CFP — 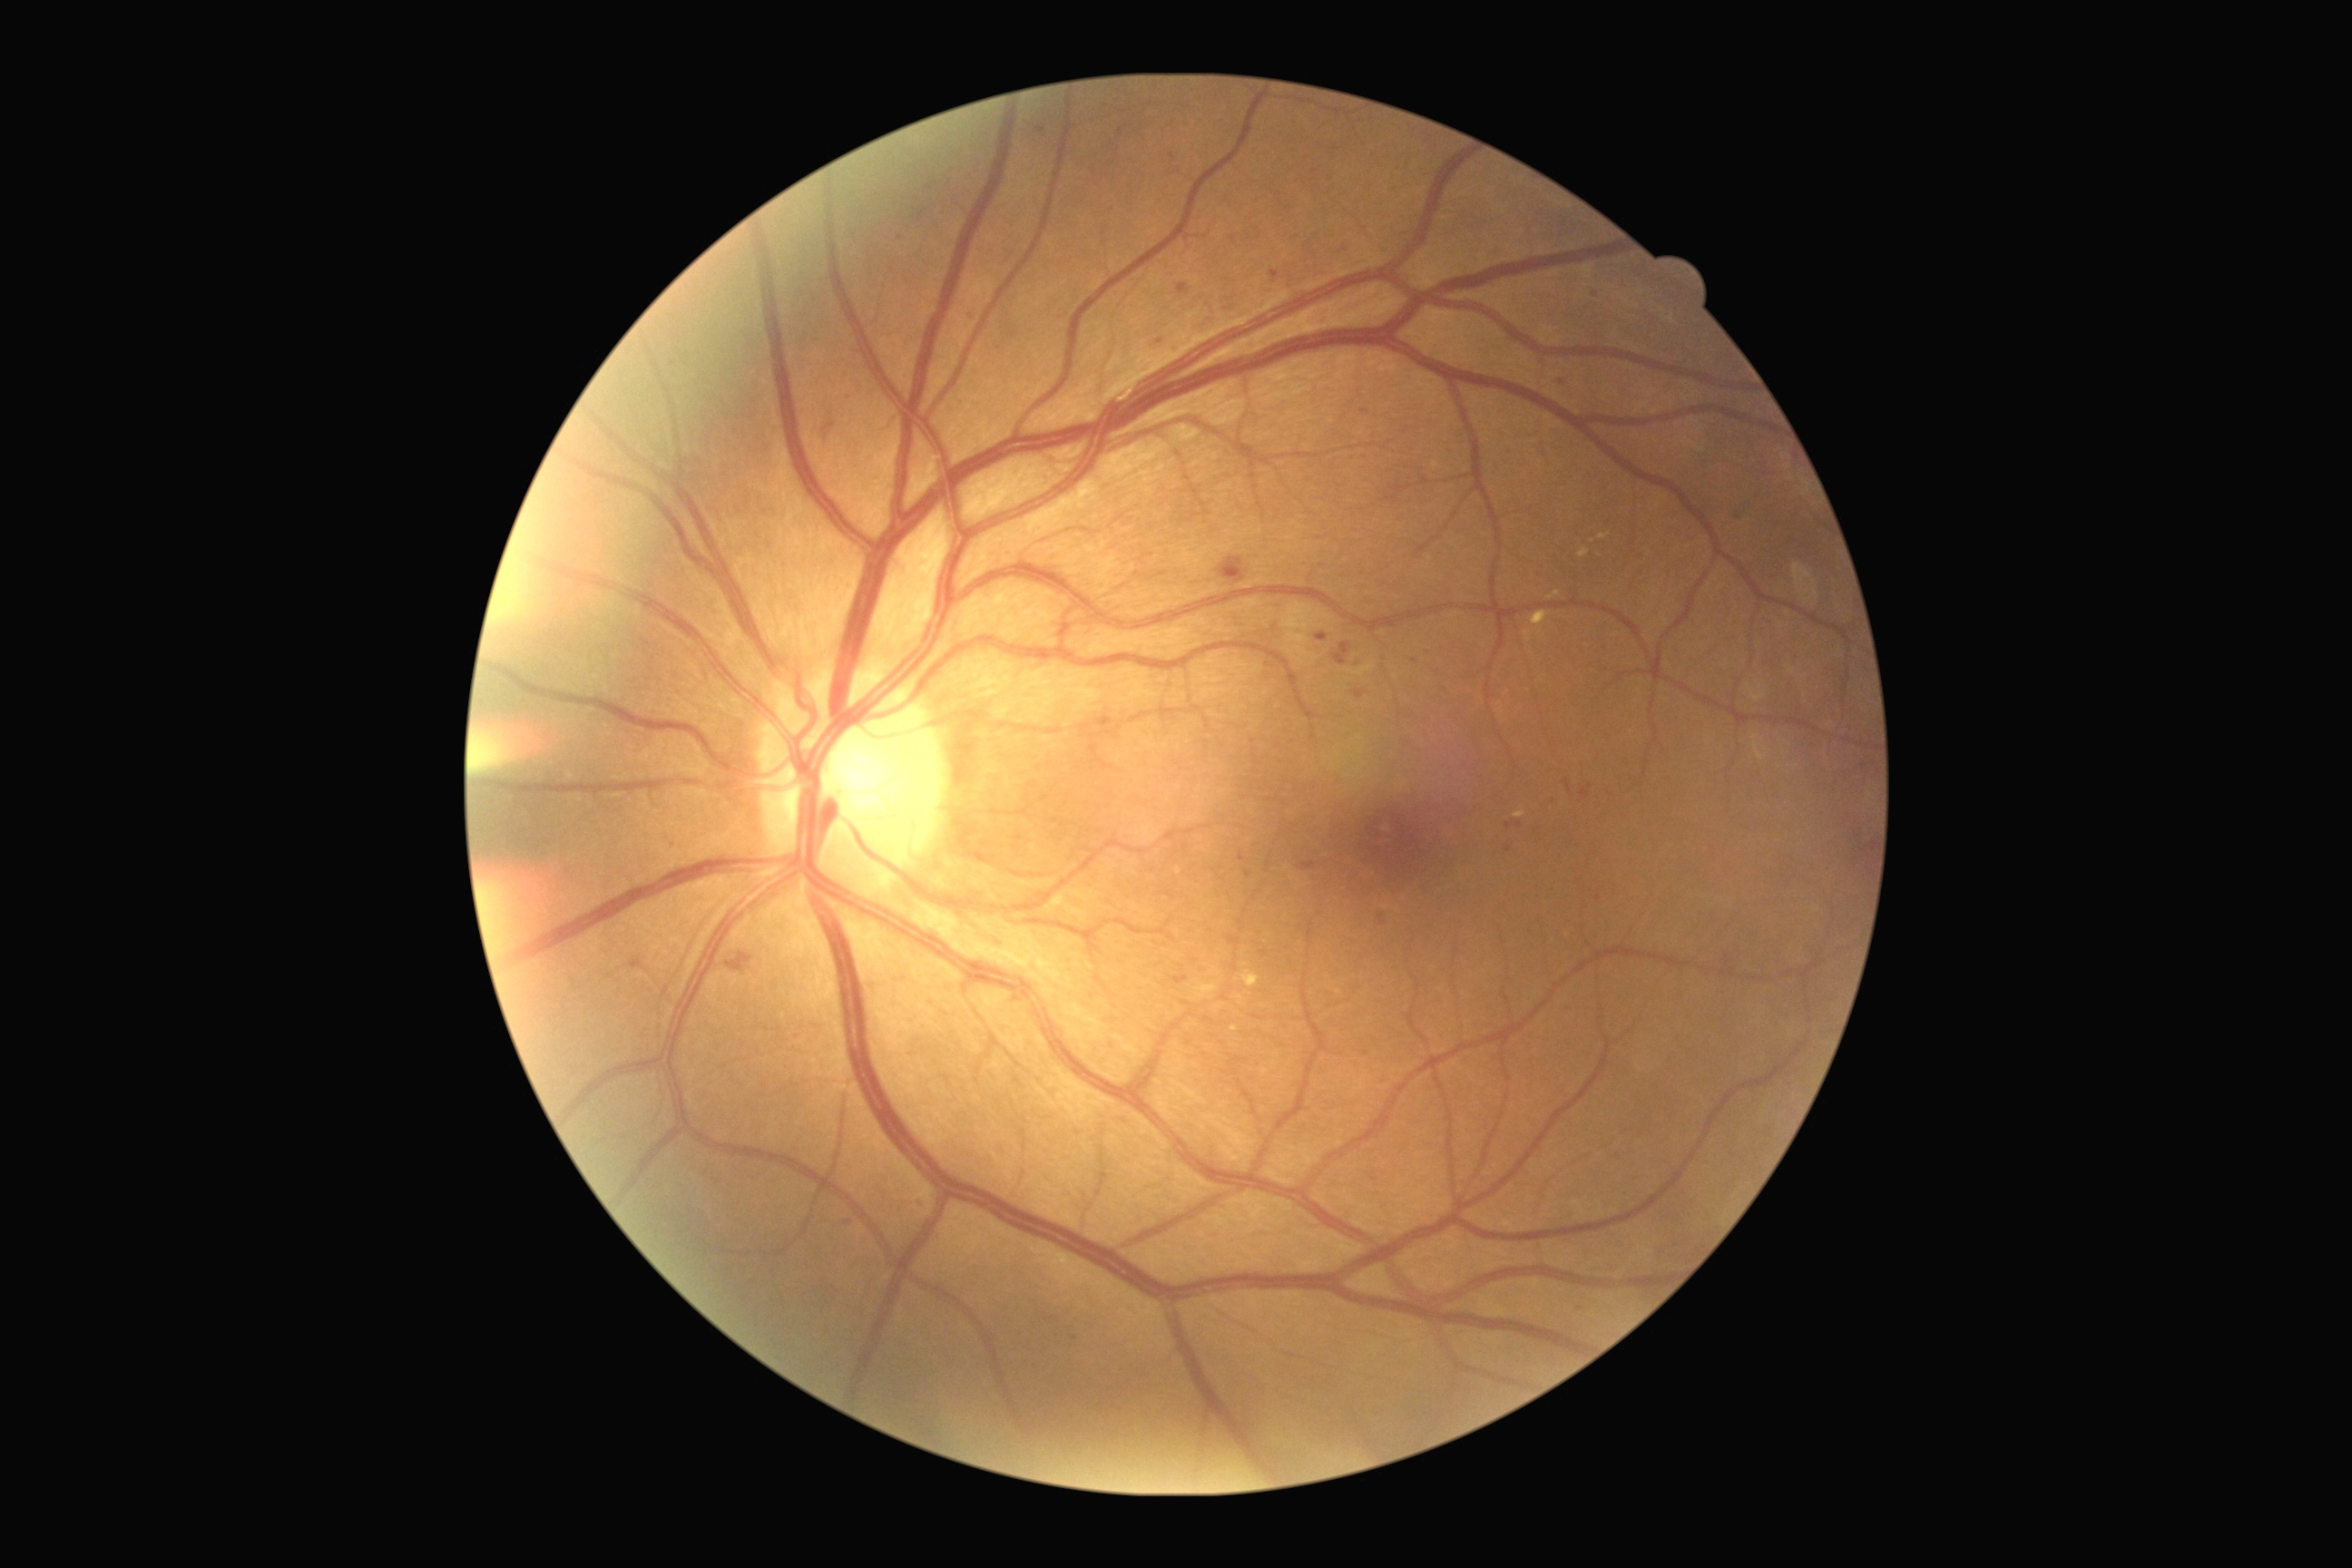

Diabetic retinopathy is grade 2
Representative lesions:
microaneurysms (continued) = region(1097, 718, 1113, 730), region(1580, 790, 1589, 799), region(914, 1199, 925, 1213), region(1177, 284, 1190, 295)
Smaller microaneurysms around pt(1521, 824), pt(1595, 294), pt(1383, 919), pt(1185, 1003), pt(1263, 954), pt(1562, 382), pt(1121, 133), pt(1013, 336), pt(1172, 157), pt(848, 1223)
soft exudates = none detected
hemorrhages = region(729, 952, 756, 981), region(1333, 643, 1351, 665), region(827, 424, 830, 440), region(1219, 558, 1246, 583), region(1725, 946, 1736, 968), region(1315, 634, 1328, 642), region(1353, 691, 1364, 700)
hard exudates (continued) = region(1524, 631, 1531, 642), region(1195, 983, 1219, 999), region(1531, 611, 1551, 627), region(1547, 593, 1562, 602), region(1578, 549, 1589, 558), region(1231, 1026, 1239, 1032), region(1237, 970, 1260, 988), region(1600, 533, 1611, 540)
Smaller hard exudates around pt(1339, 992)